Image size 1659x2212 — 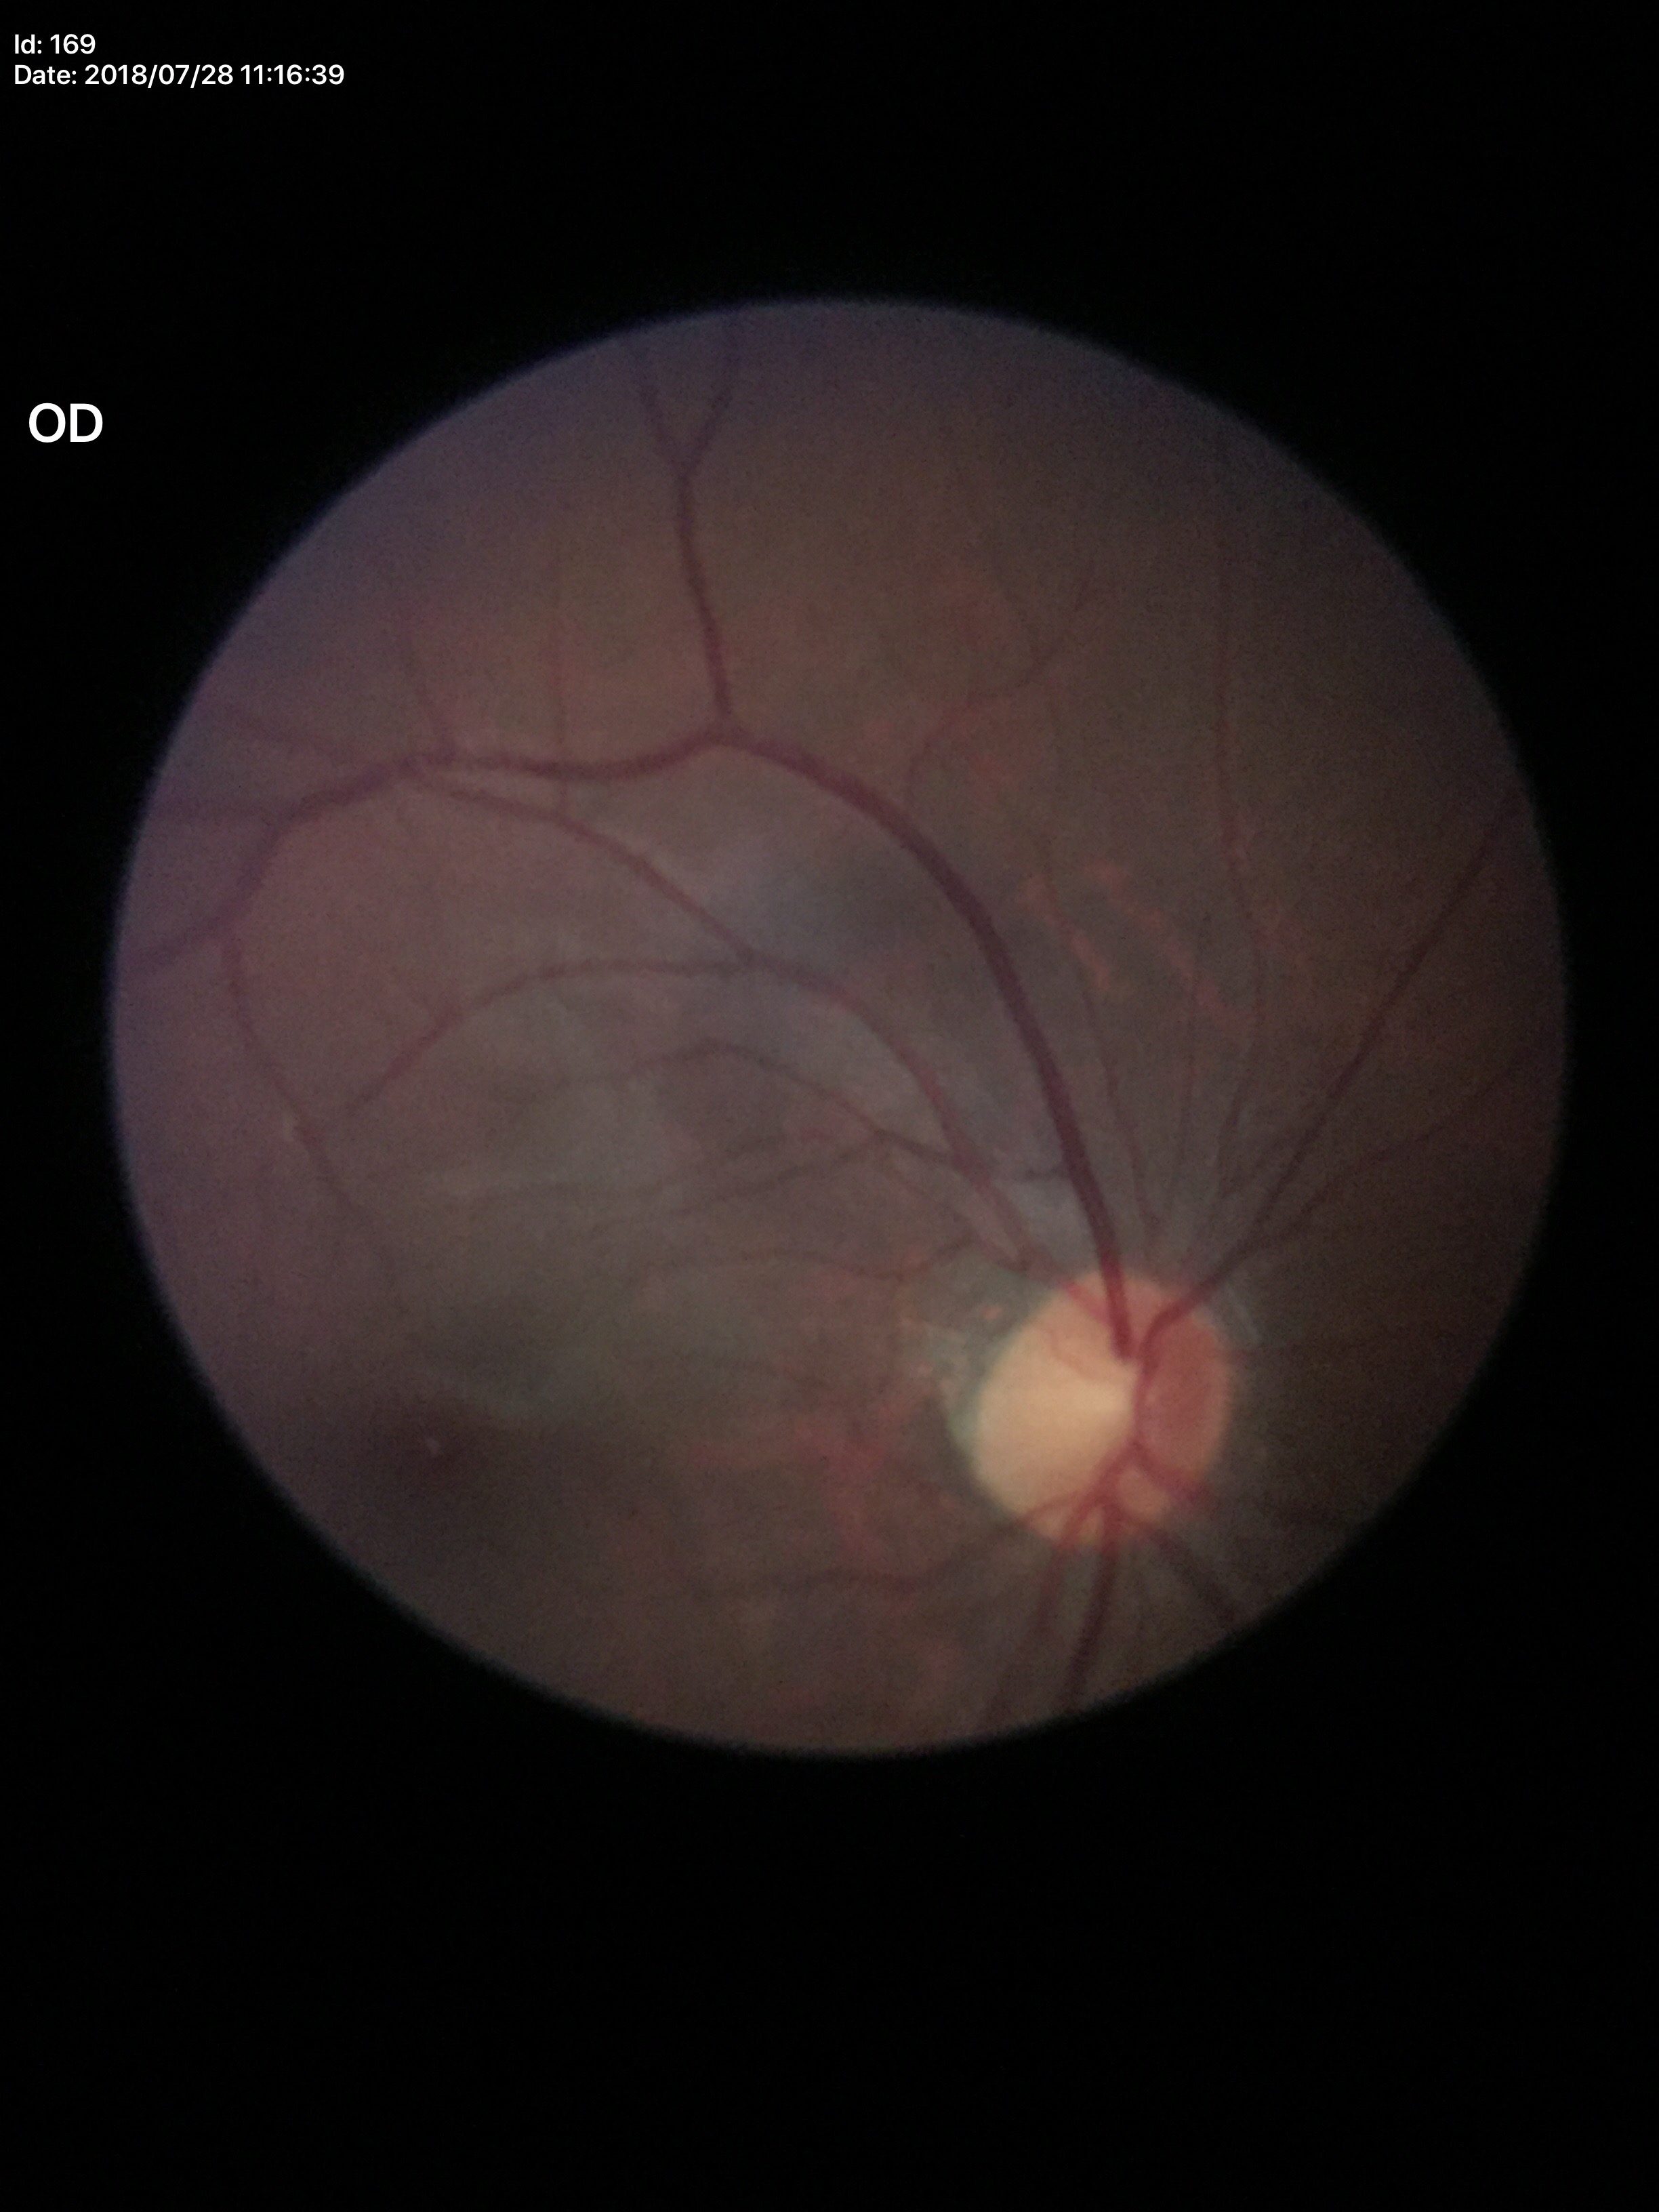
No glaucomatous optic neuropathy.
Horizontal CDR (HCDR) is 0.49.
Vertical CDR (VCDR): 0.52.